CFP; 2352x1568px; 45° field of view — 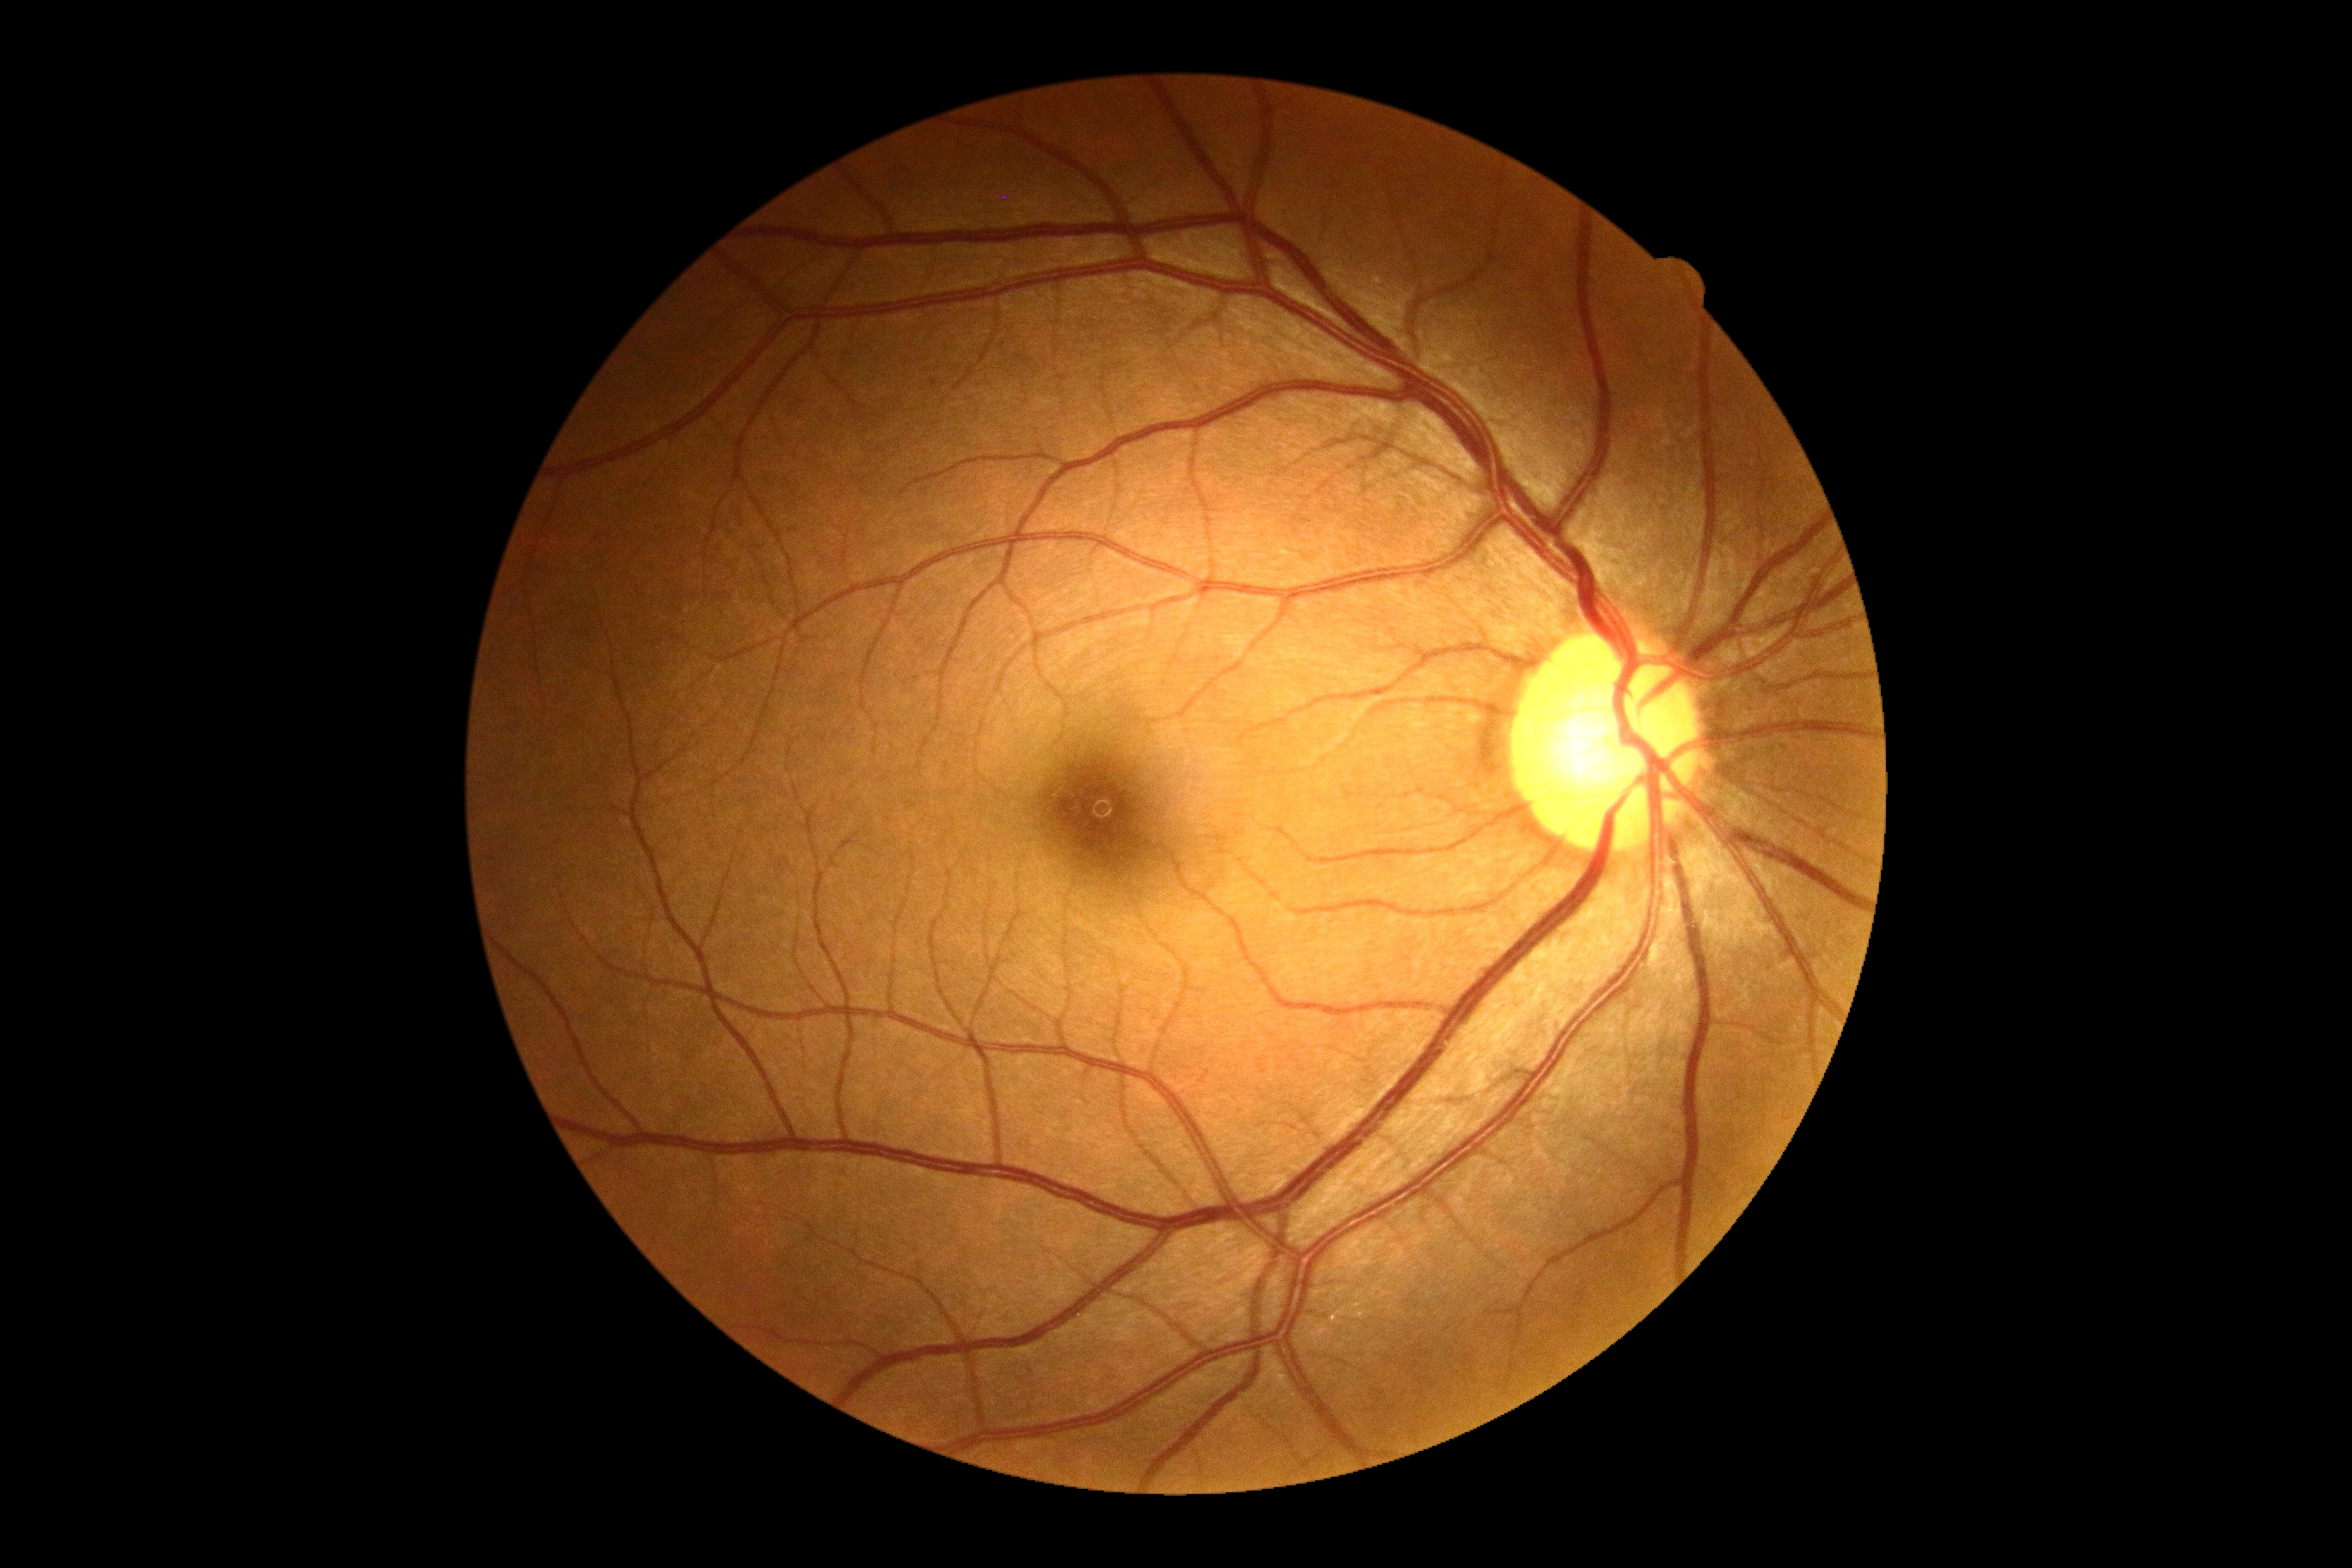
Diabetic retinopathy severity: grade 0 (no apparent retinopathy) — no visible signs of diabetic retinopathy.